45° field of view. Color fundus photograph. Davis DR grading: 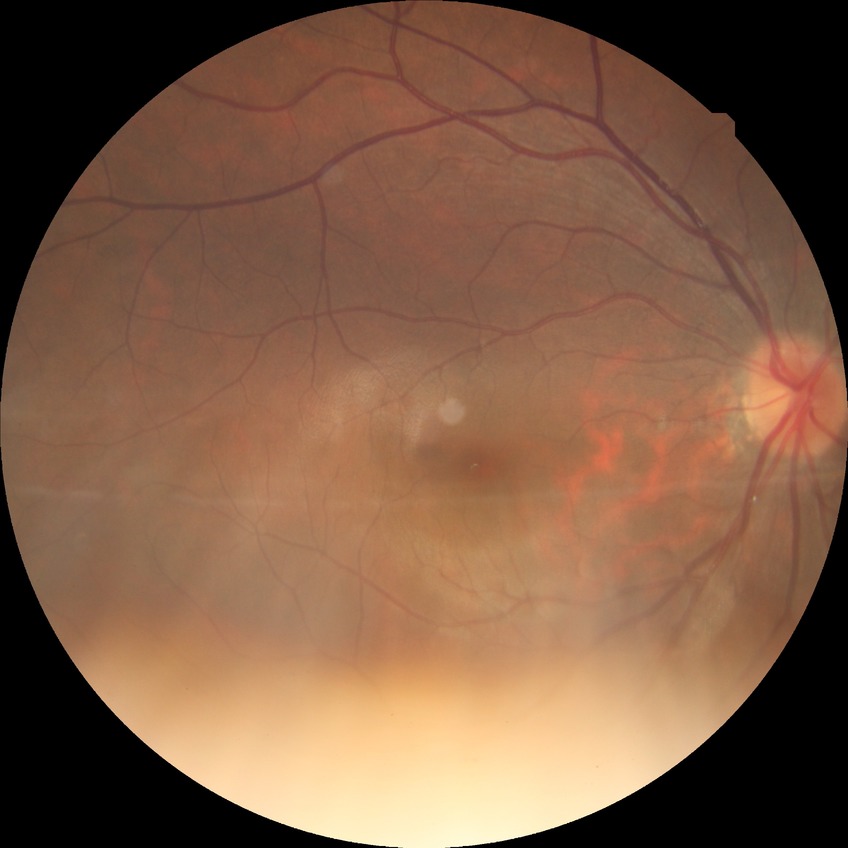 Modified Davis grading is no diabetic retinopathy.